Camera: Clarity RetCam 3 (130° FOV). Pediatric retinal photograph (wide-field)
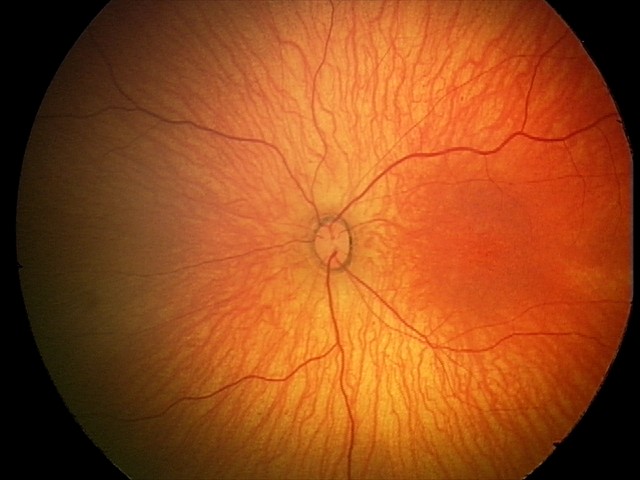 Normal screening examination.